Acquired with a NIDEK AFC-230. No pharmacologic dilation:
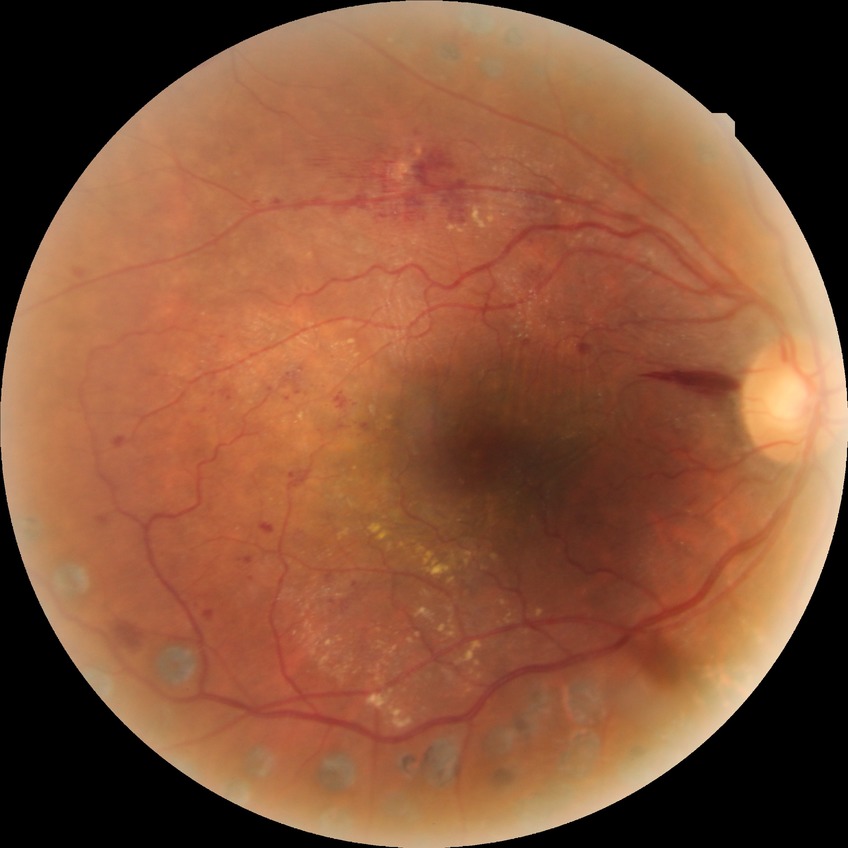 DR stage is PDR.